Captured after pupil dilation: 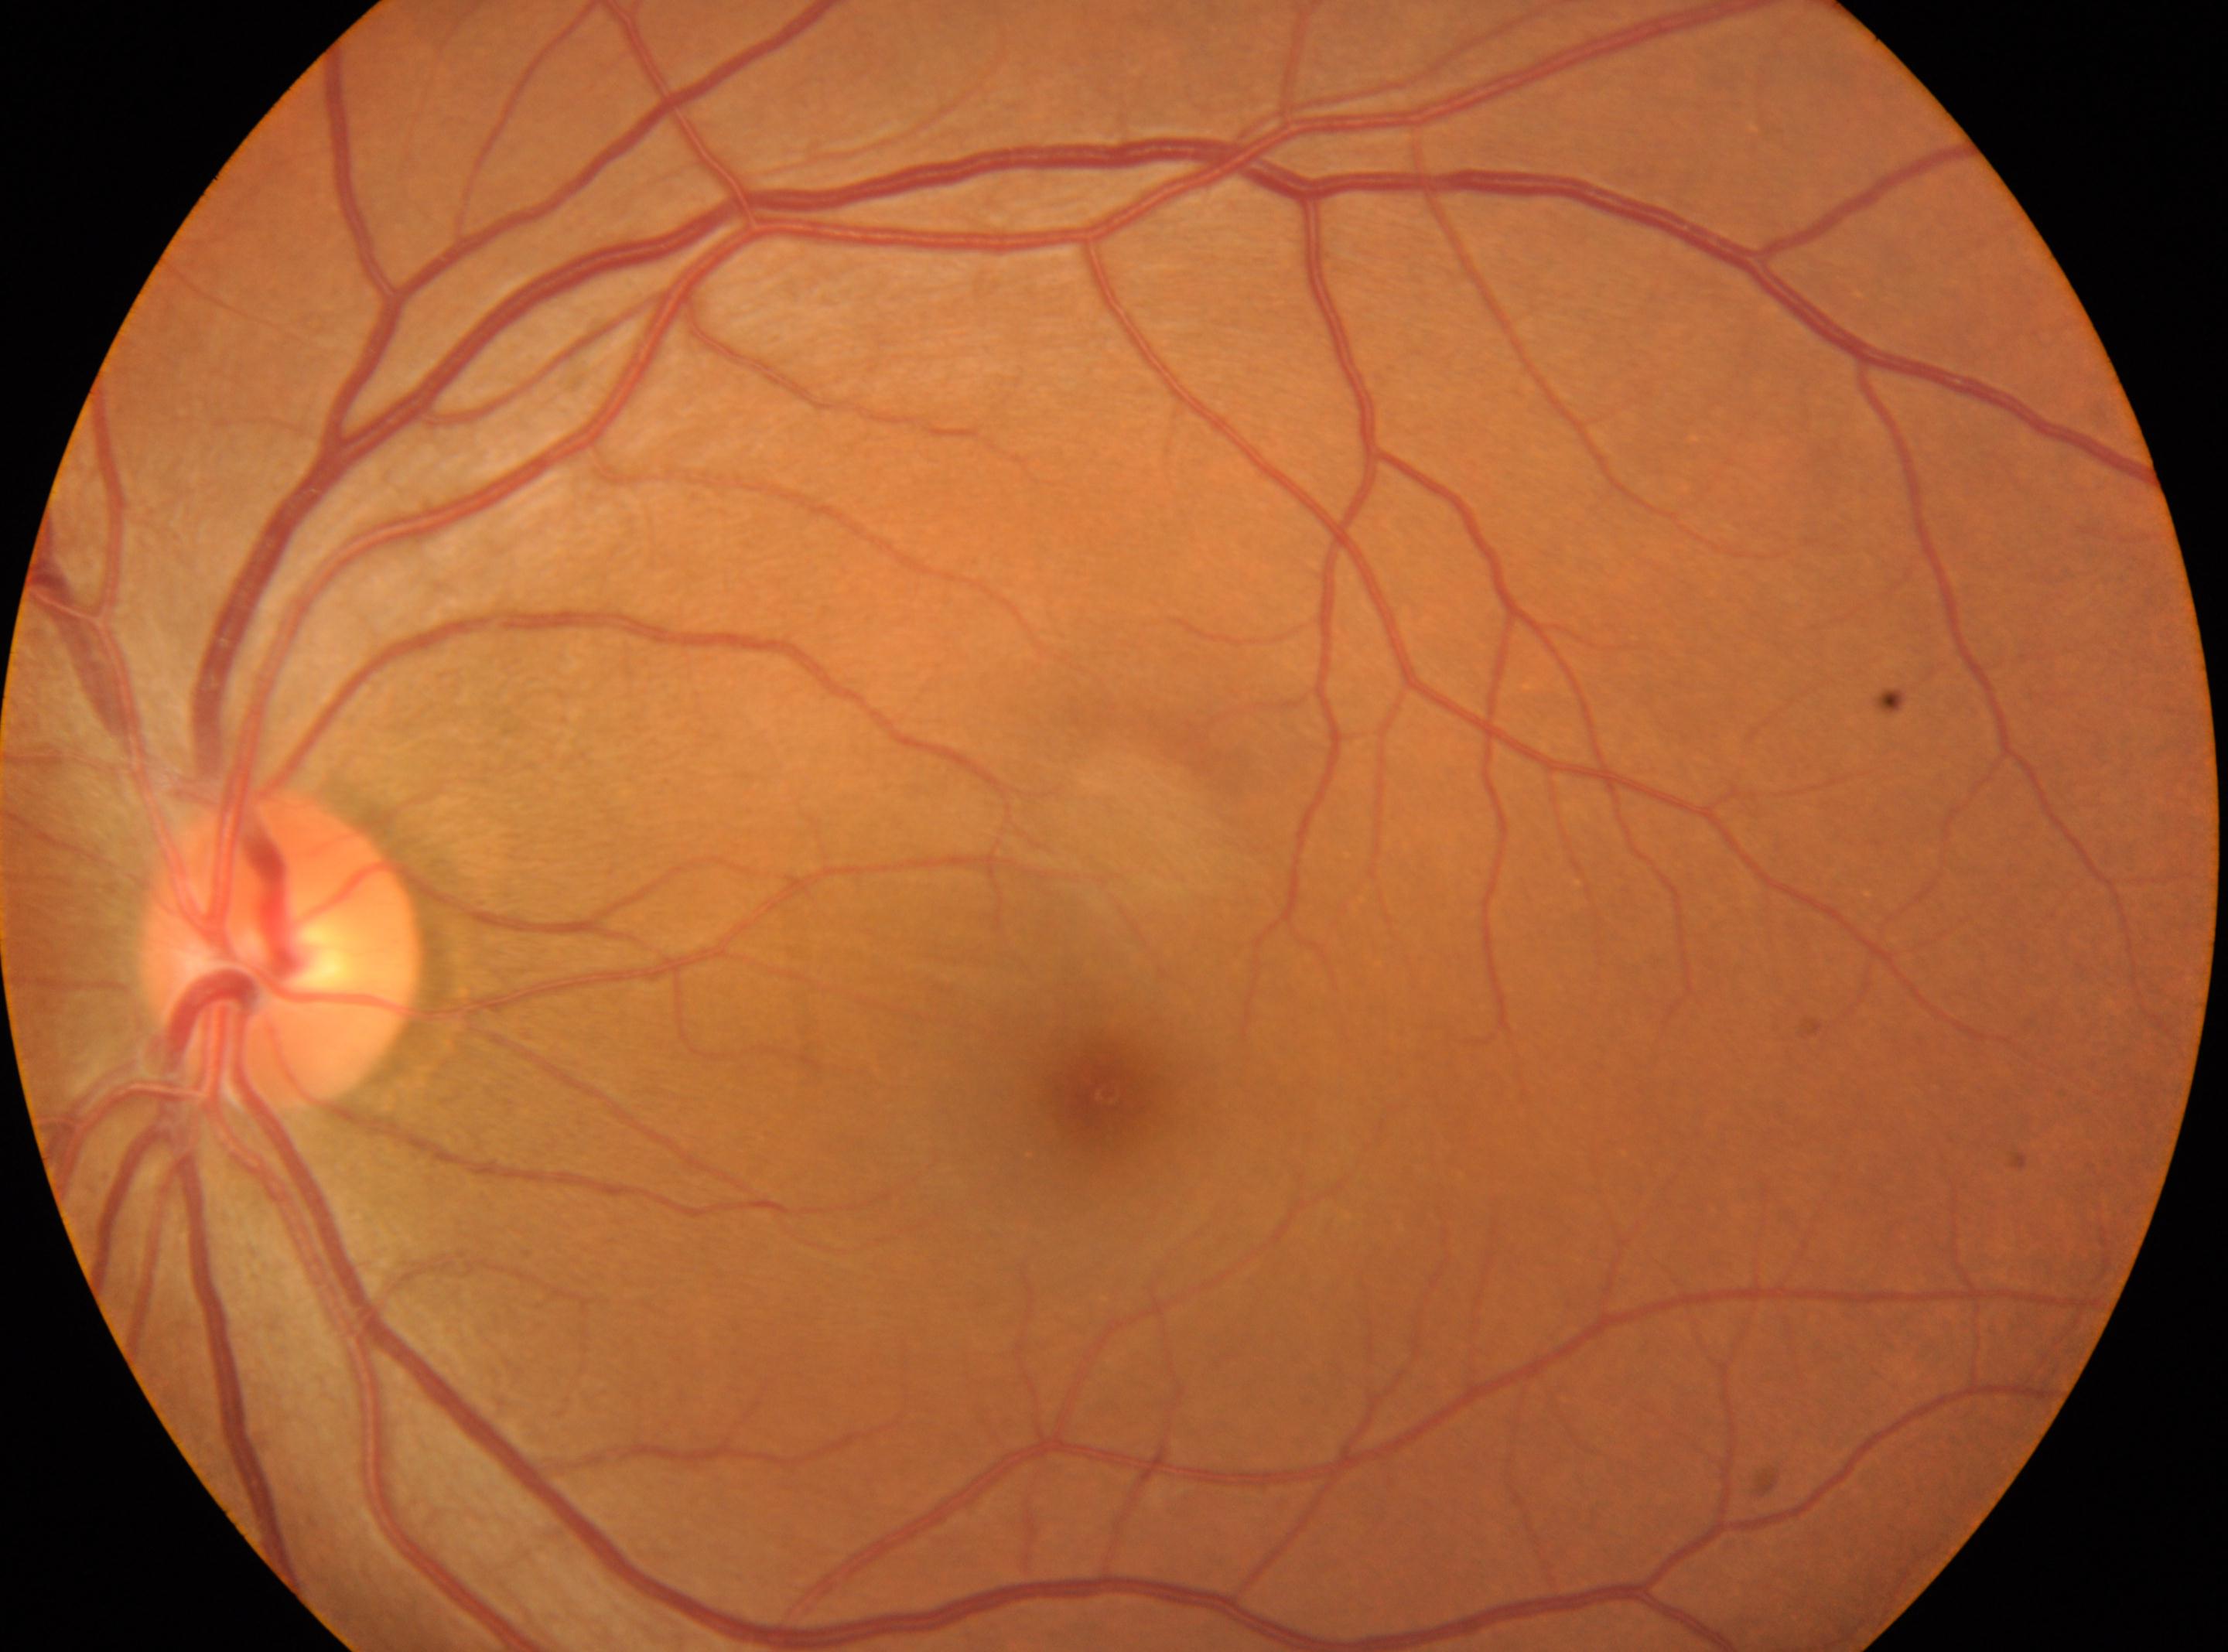 {
  "fovea": "x=1108, y=1092",
  "dr_grade": "0 — no visible signs of diabetic retinopathy",
  "optic_disc": "x=282, y=954",
  "dr_impression": "No apparent diabetic retinopathy",
  "eye": "the left eye"
}